45° FOV; 2352x1568px; fundus photo — 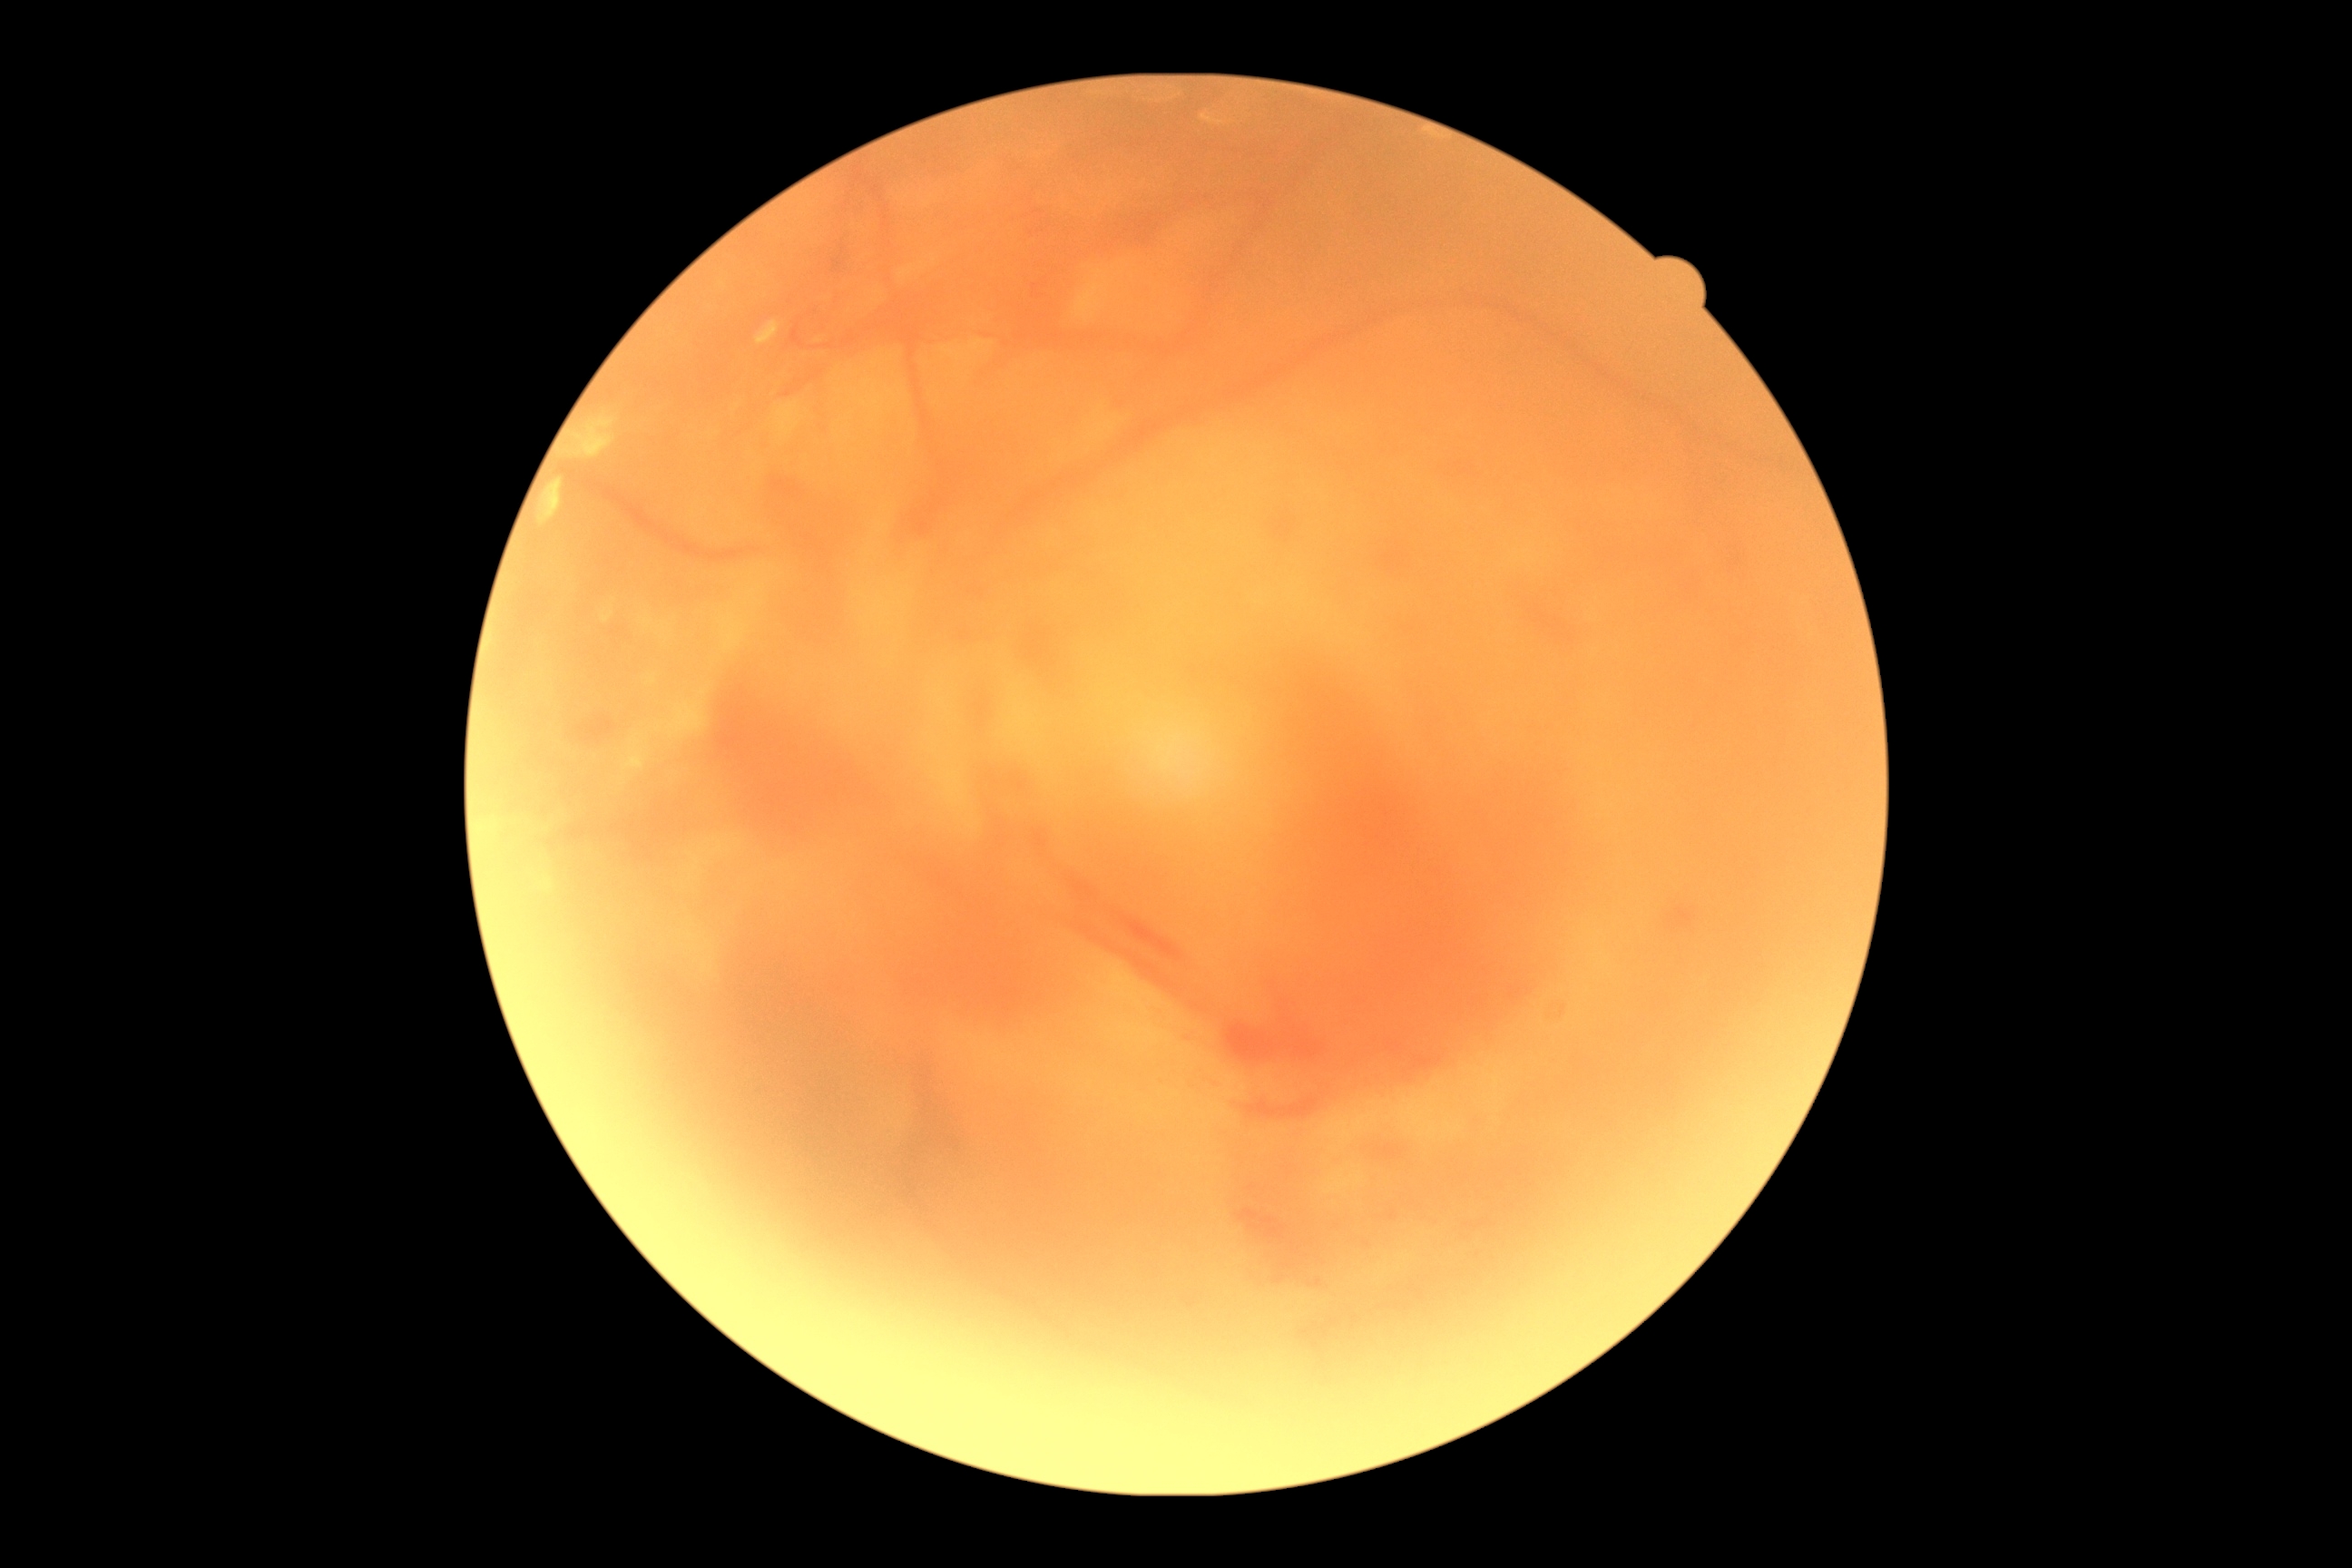

- diabetic retinopathy (DR) — 4/4